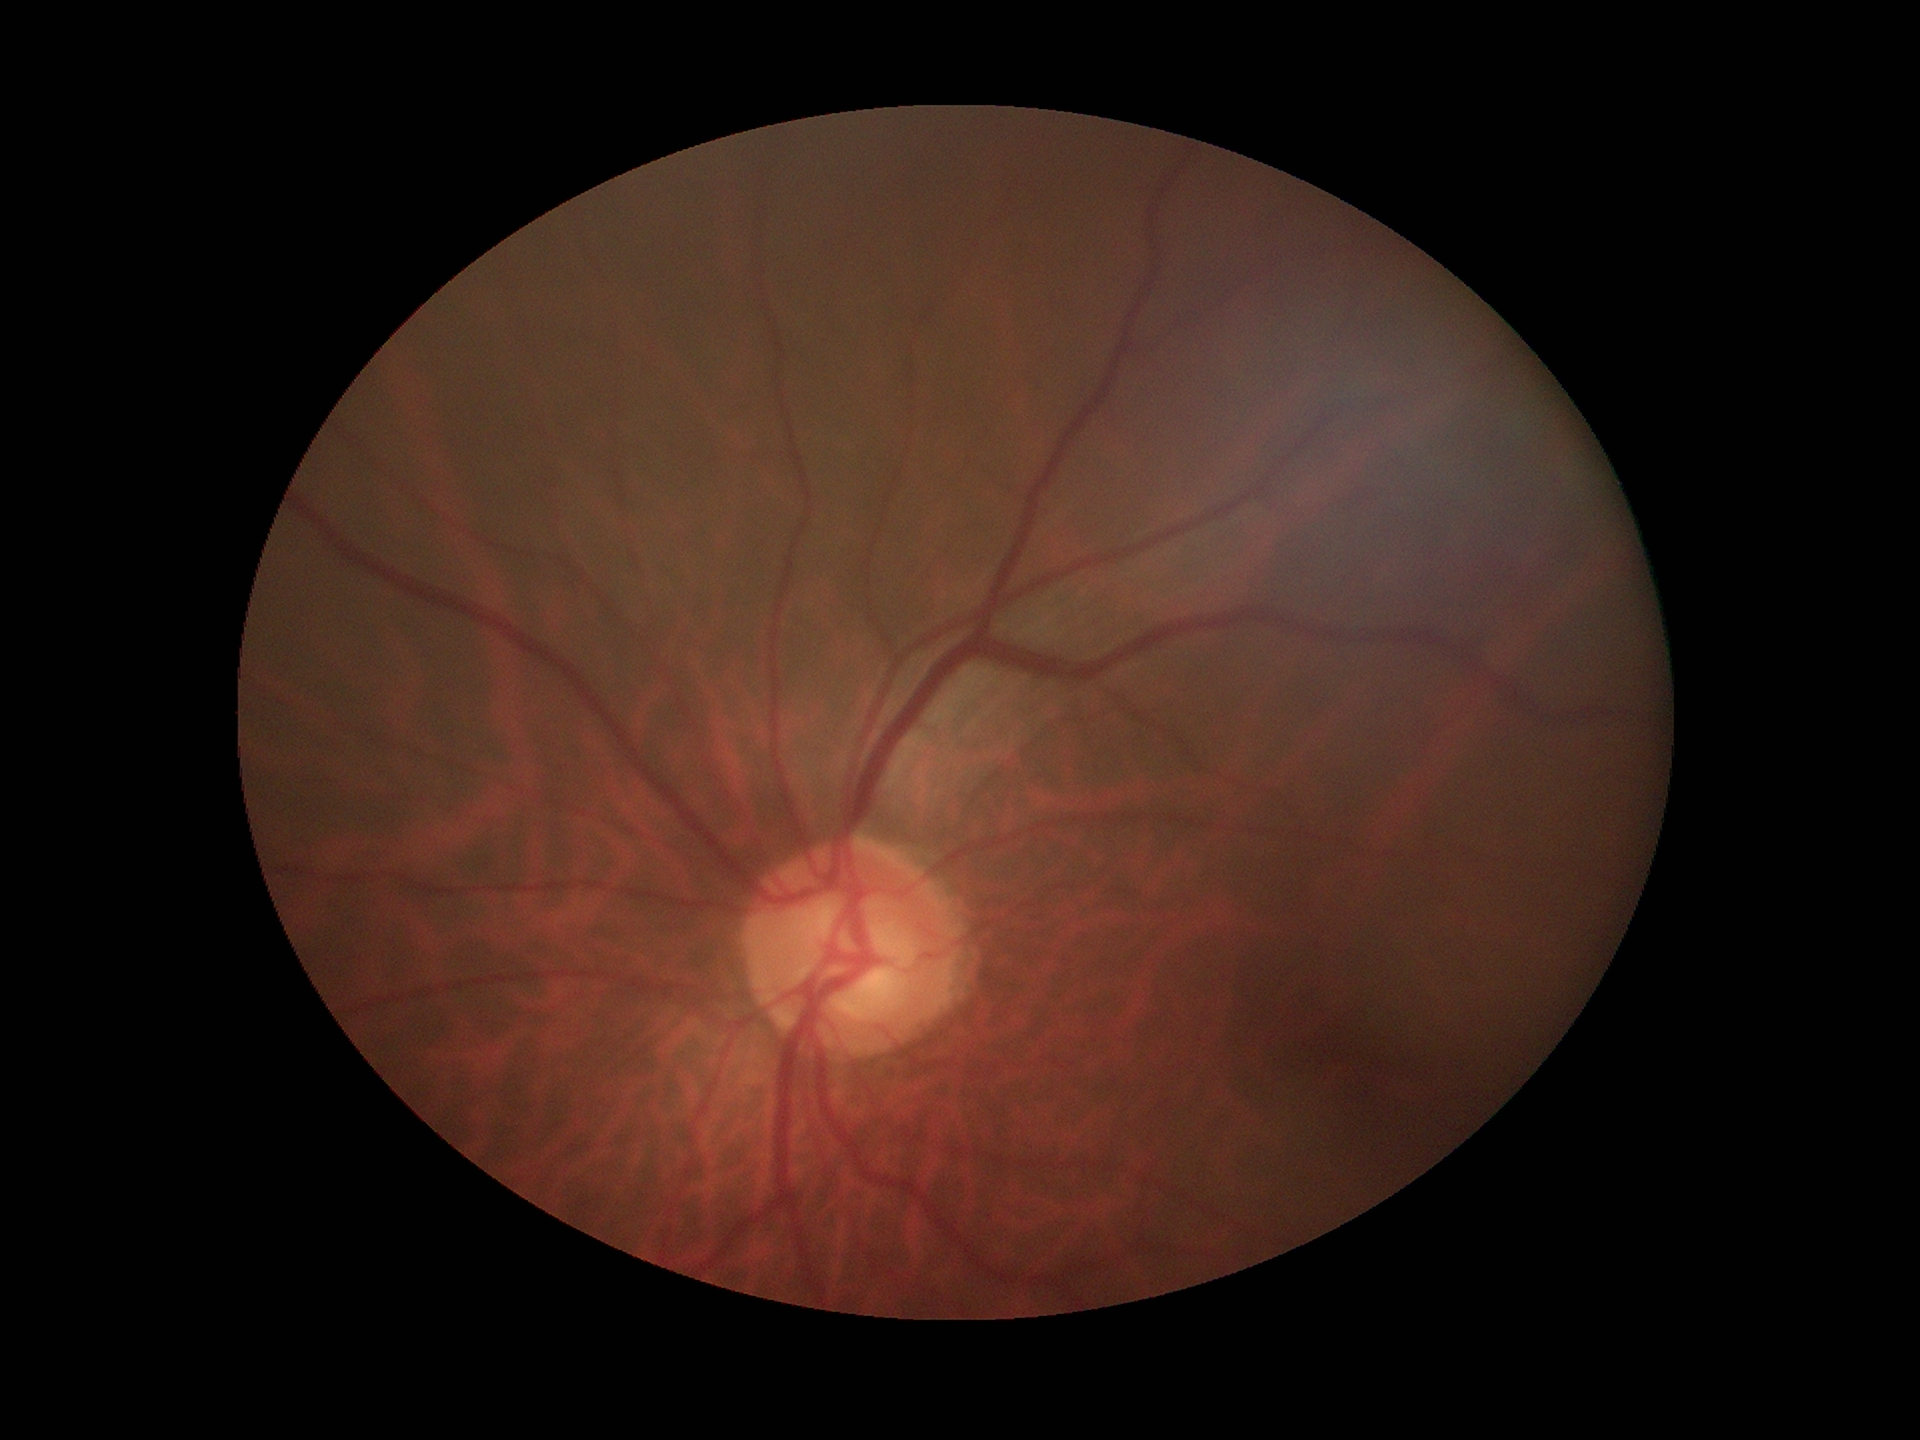

Suspect for glaucomatous optic neuropathy (4/5 graders called glaucoma suspect). Vertical cup-disc ratio is 0.63. Horizontal CDR of 0.62.